DR severity per modified Davis staging · acquired with a NIDEK AFC-230
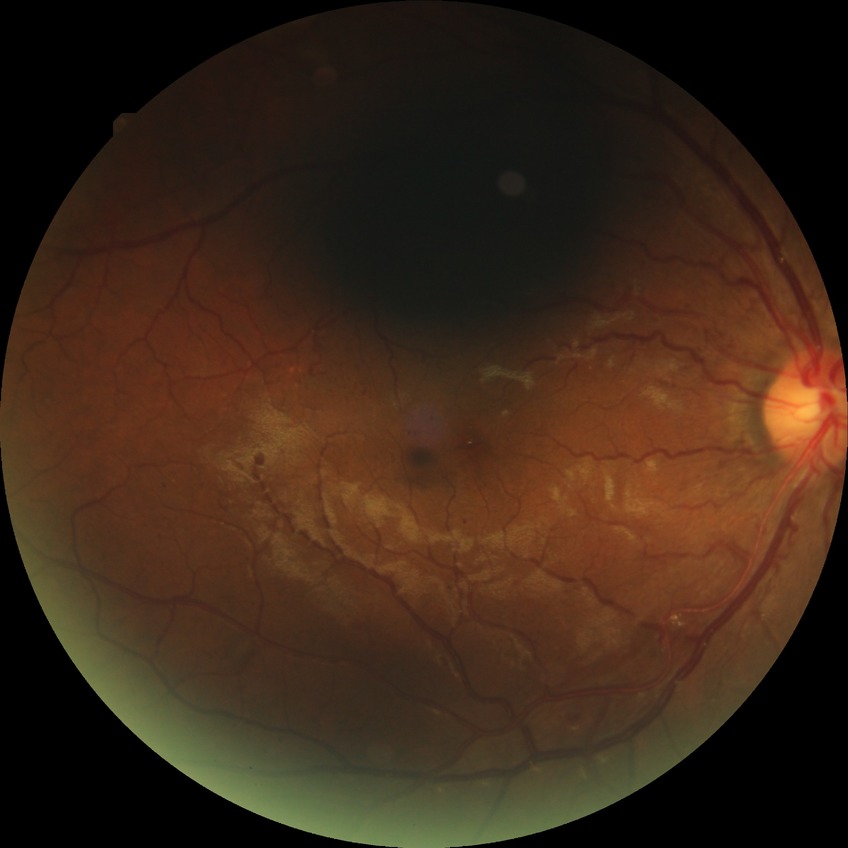

DR severity is PPDR.